Wide-field contact fundus photograph of an infant
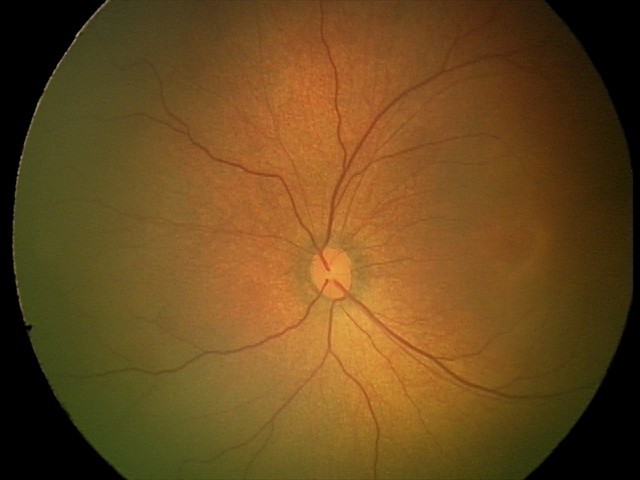
Diagnosis = physiological appearance.